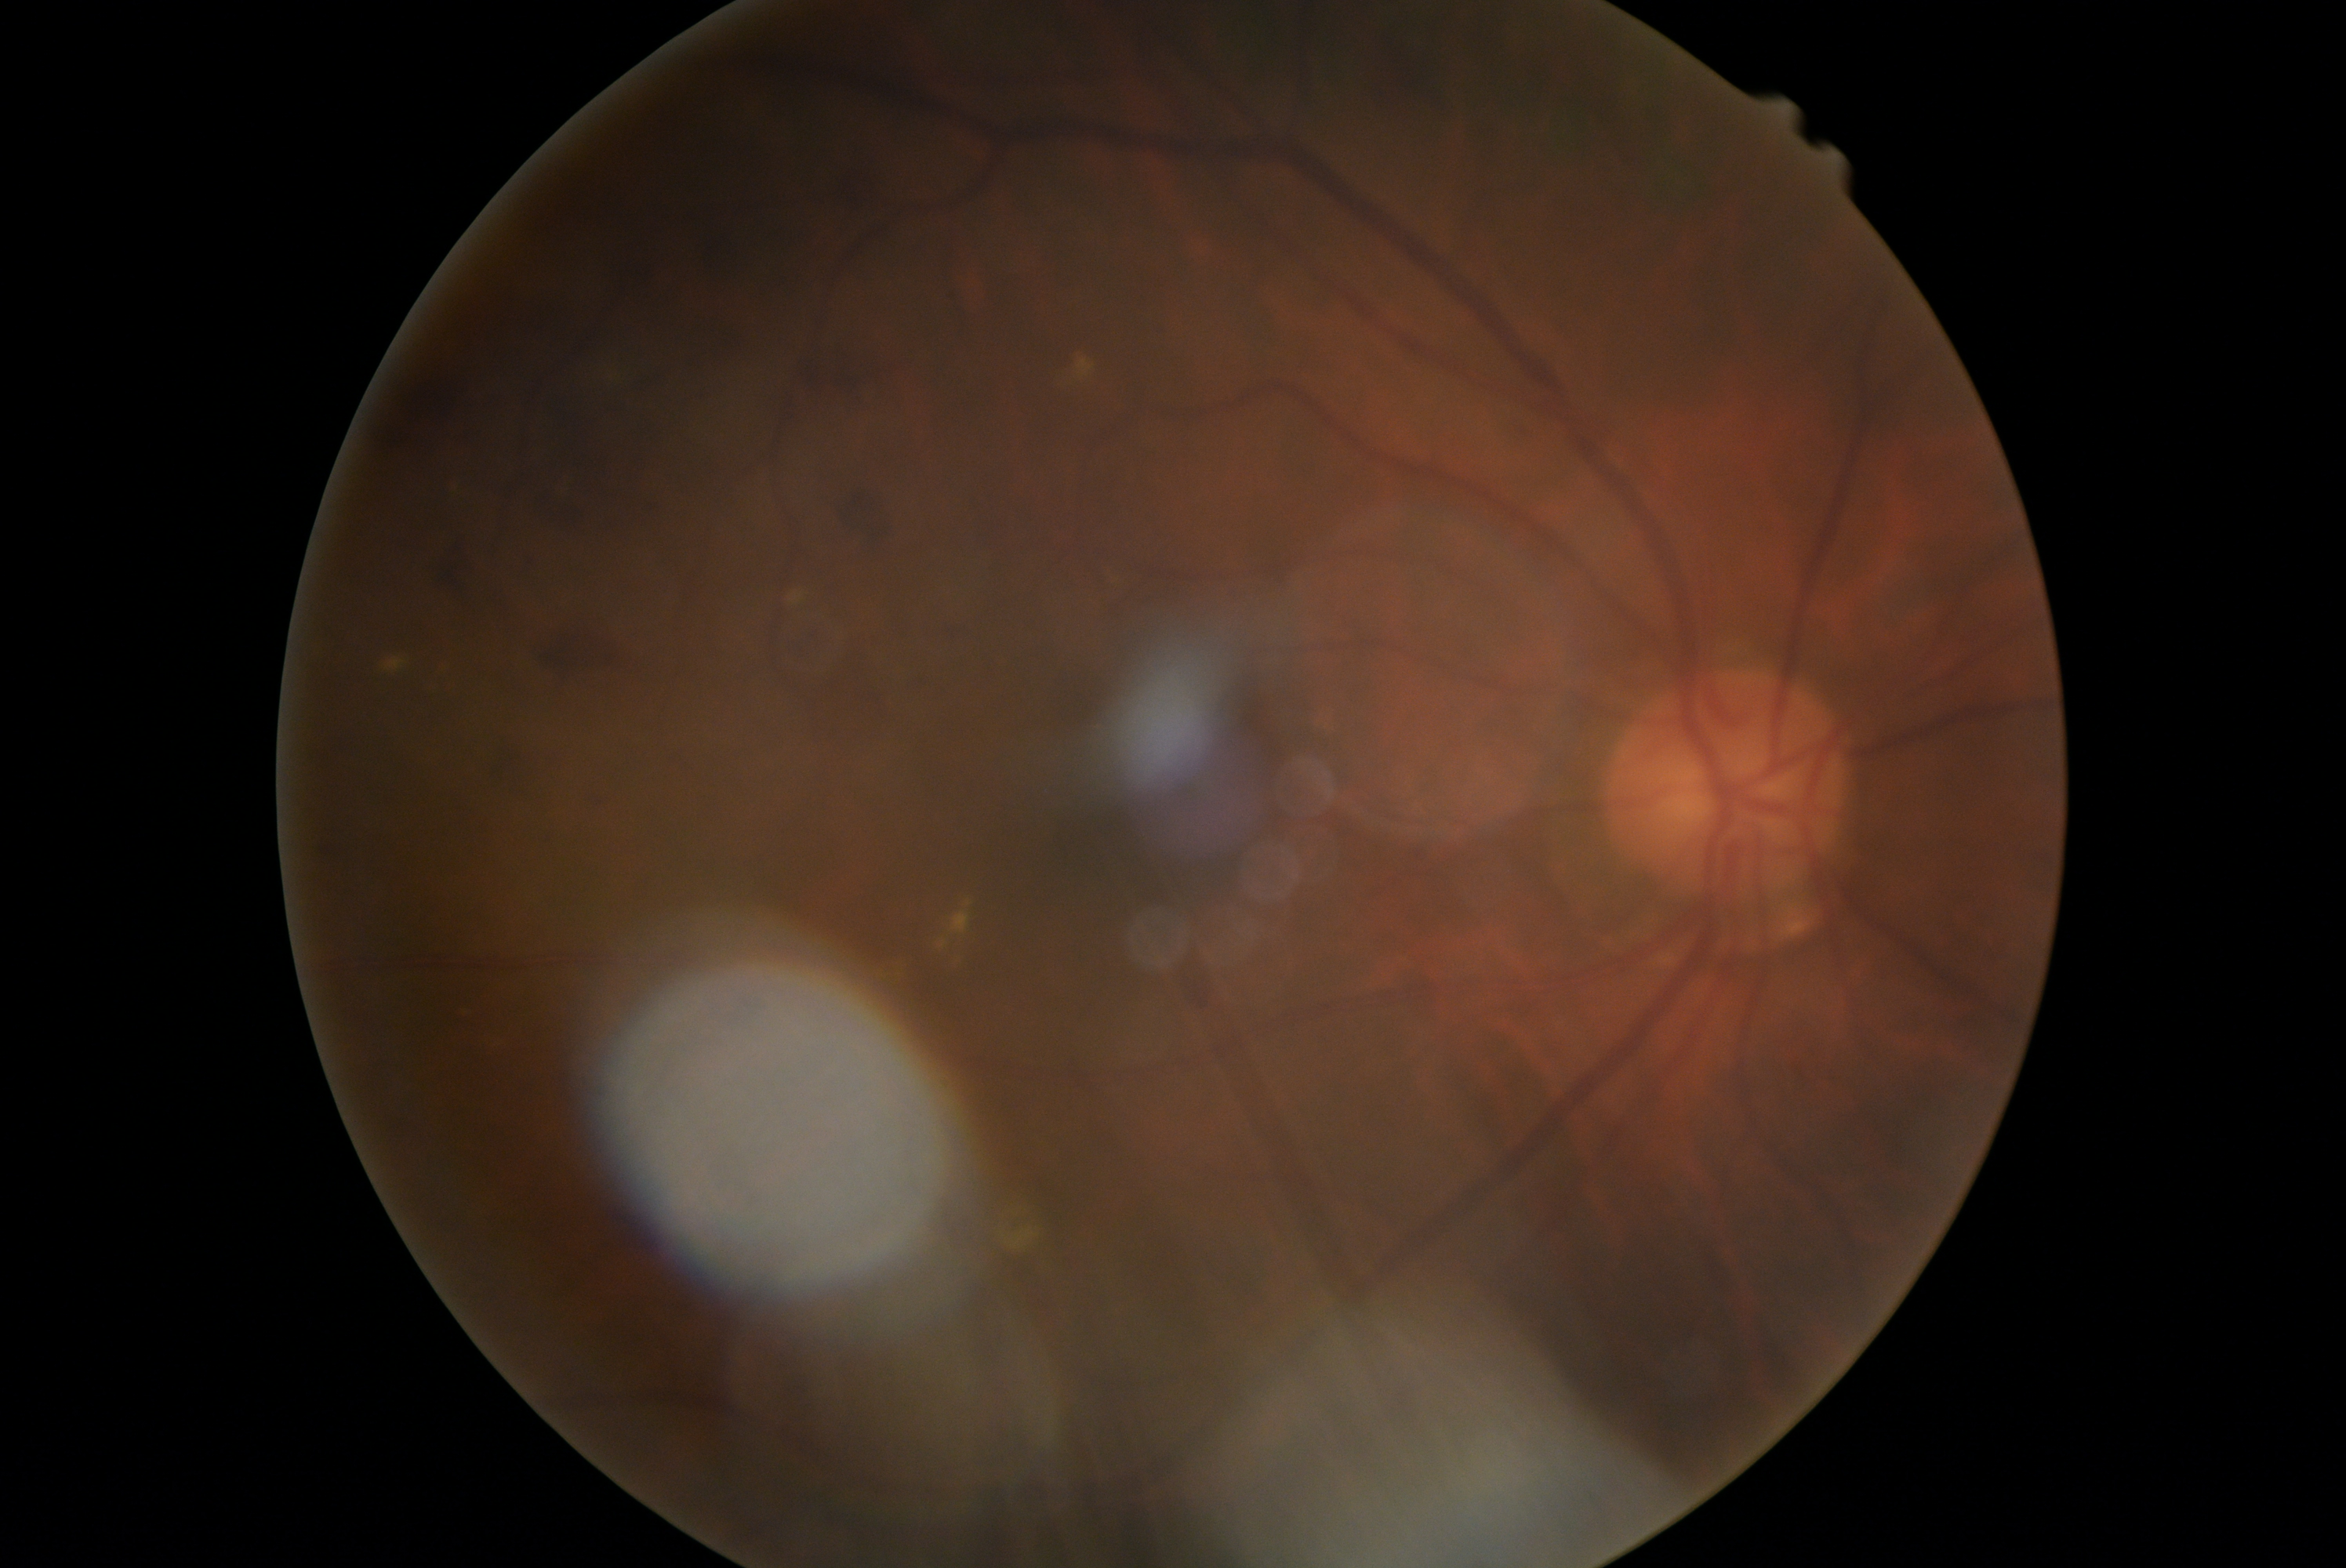

Disease class: non-proliferative diabetic retinopathy. Diabetic retinopathy is 2.